130° field of view (Clarity RetCam 3). Wide-field fundus photograph from neonatal ROP screening:
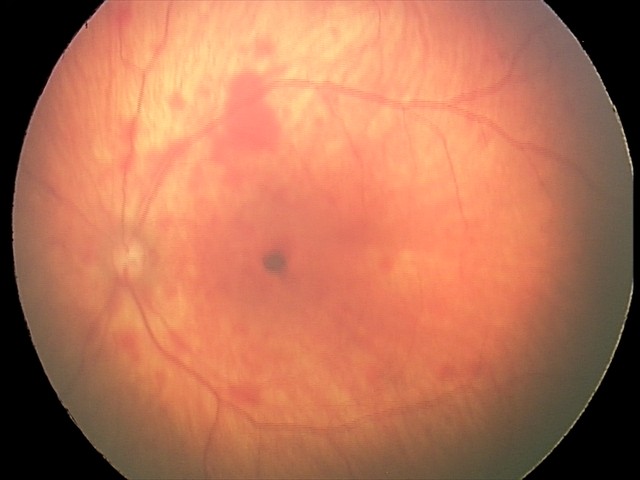

Screening examination consistent with retinal hemorrhages.